Wide-field fundus image from infant ROP screening; image size 1240x1240.
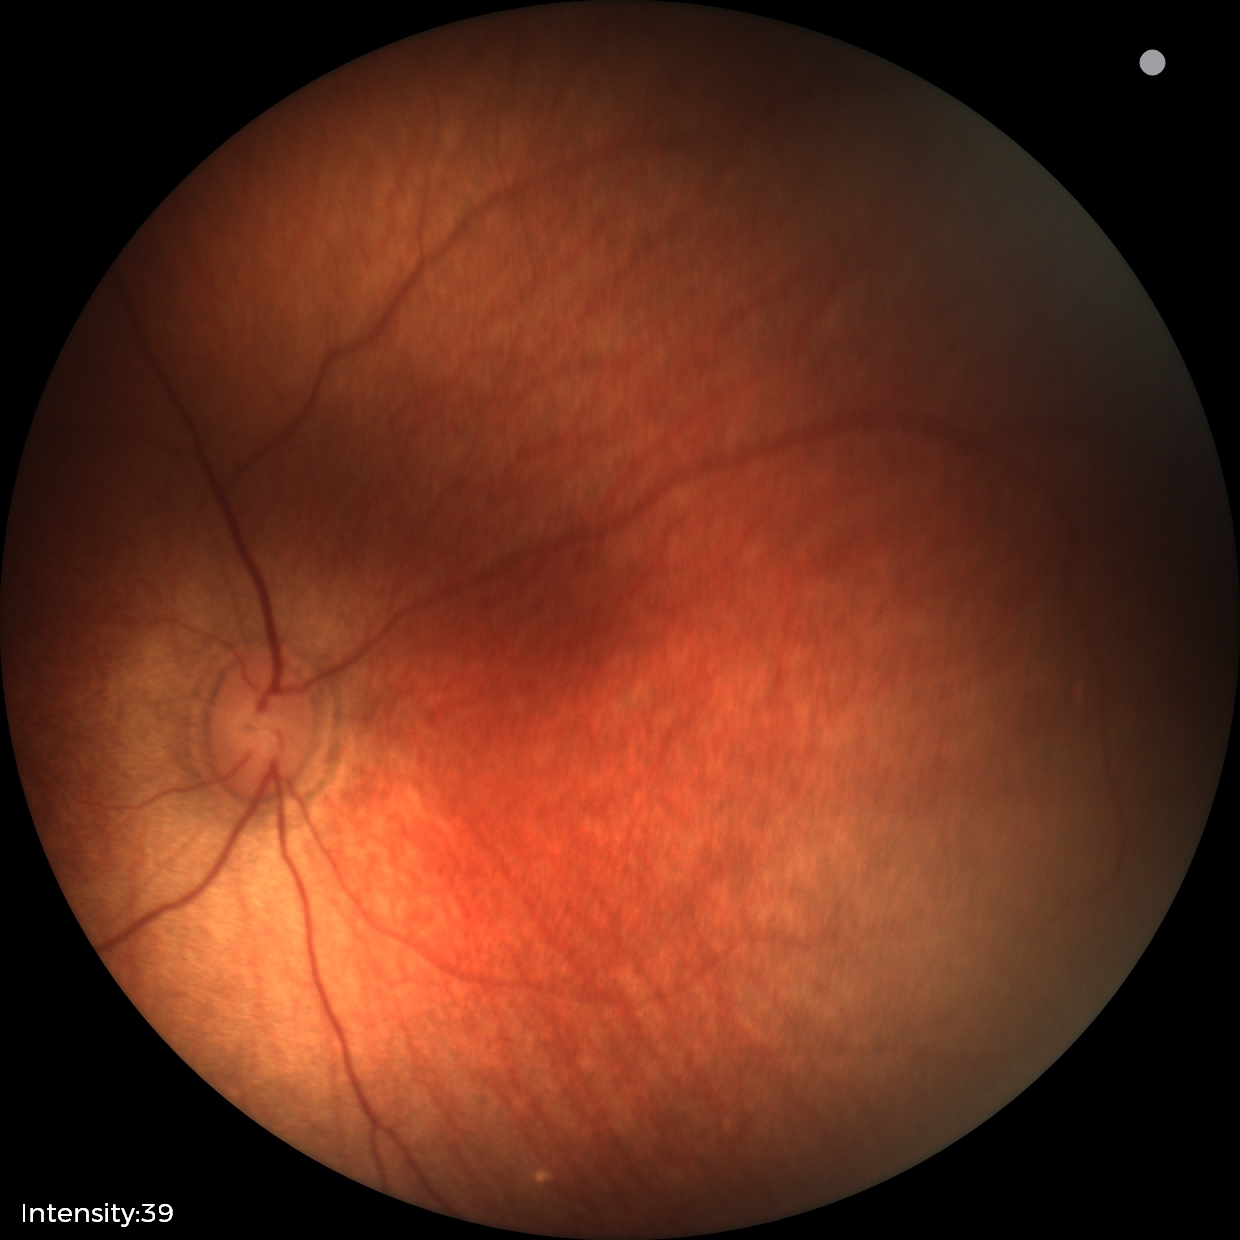
No retinal pathology identified on screening.